FOV: 45 degrees.
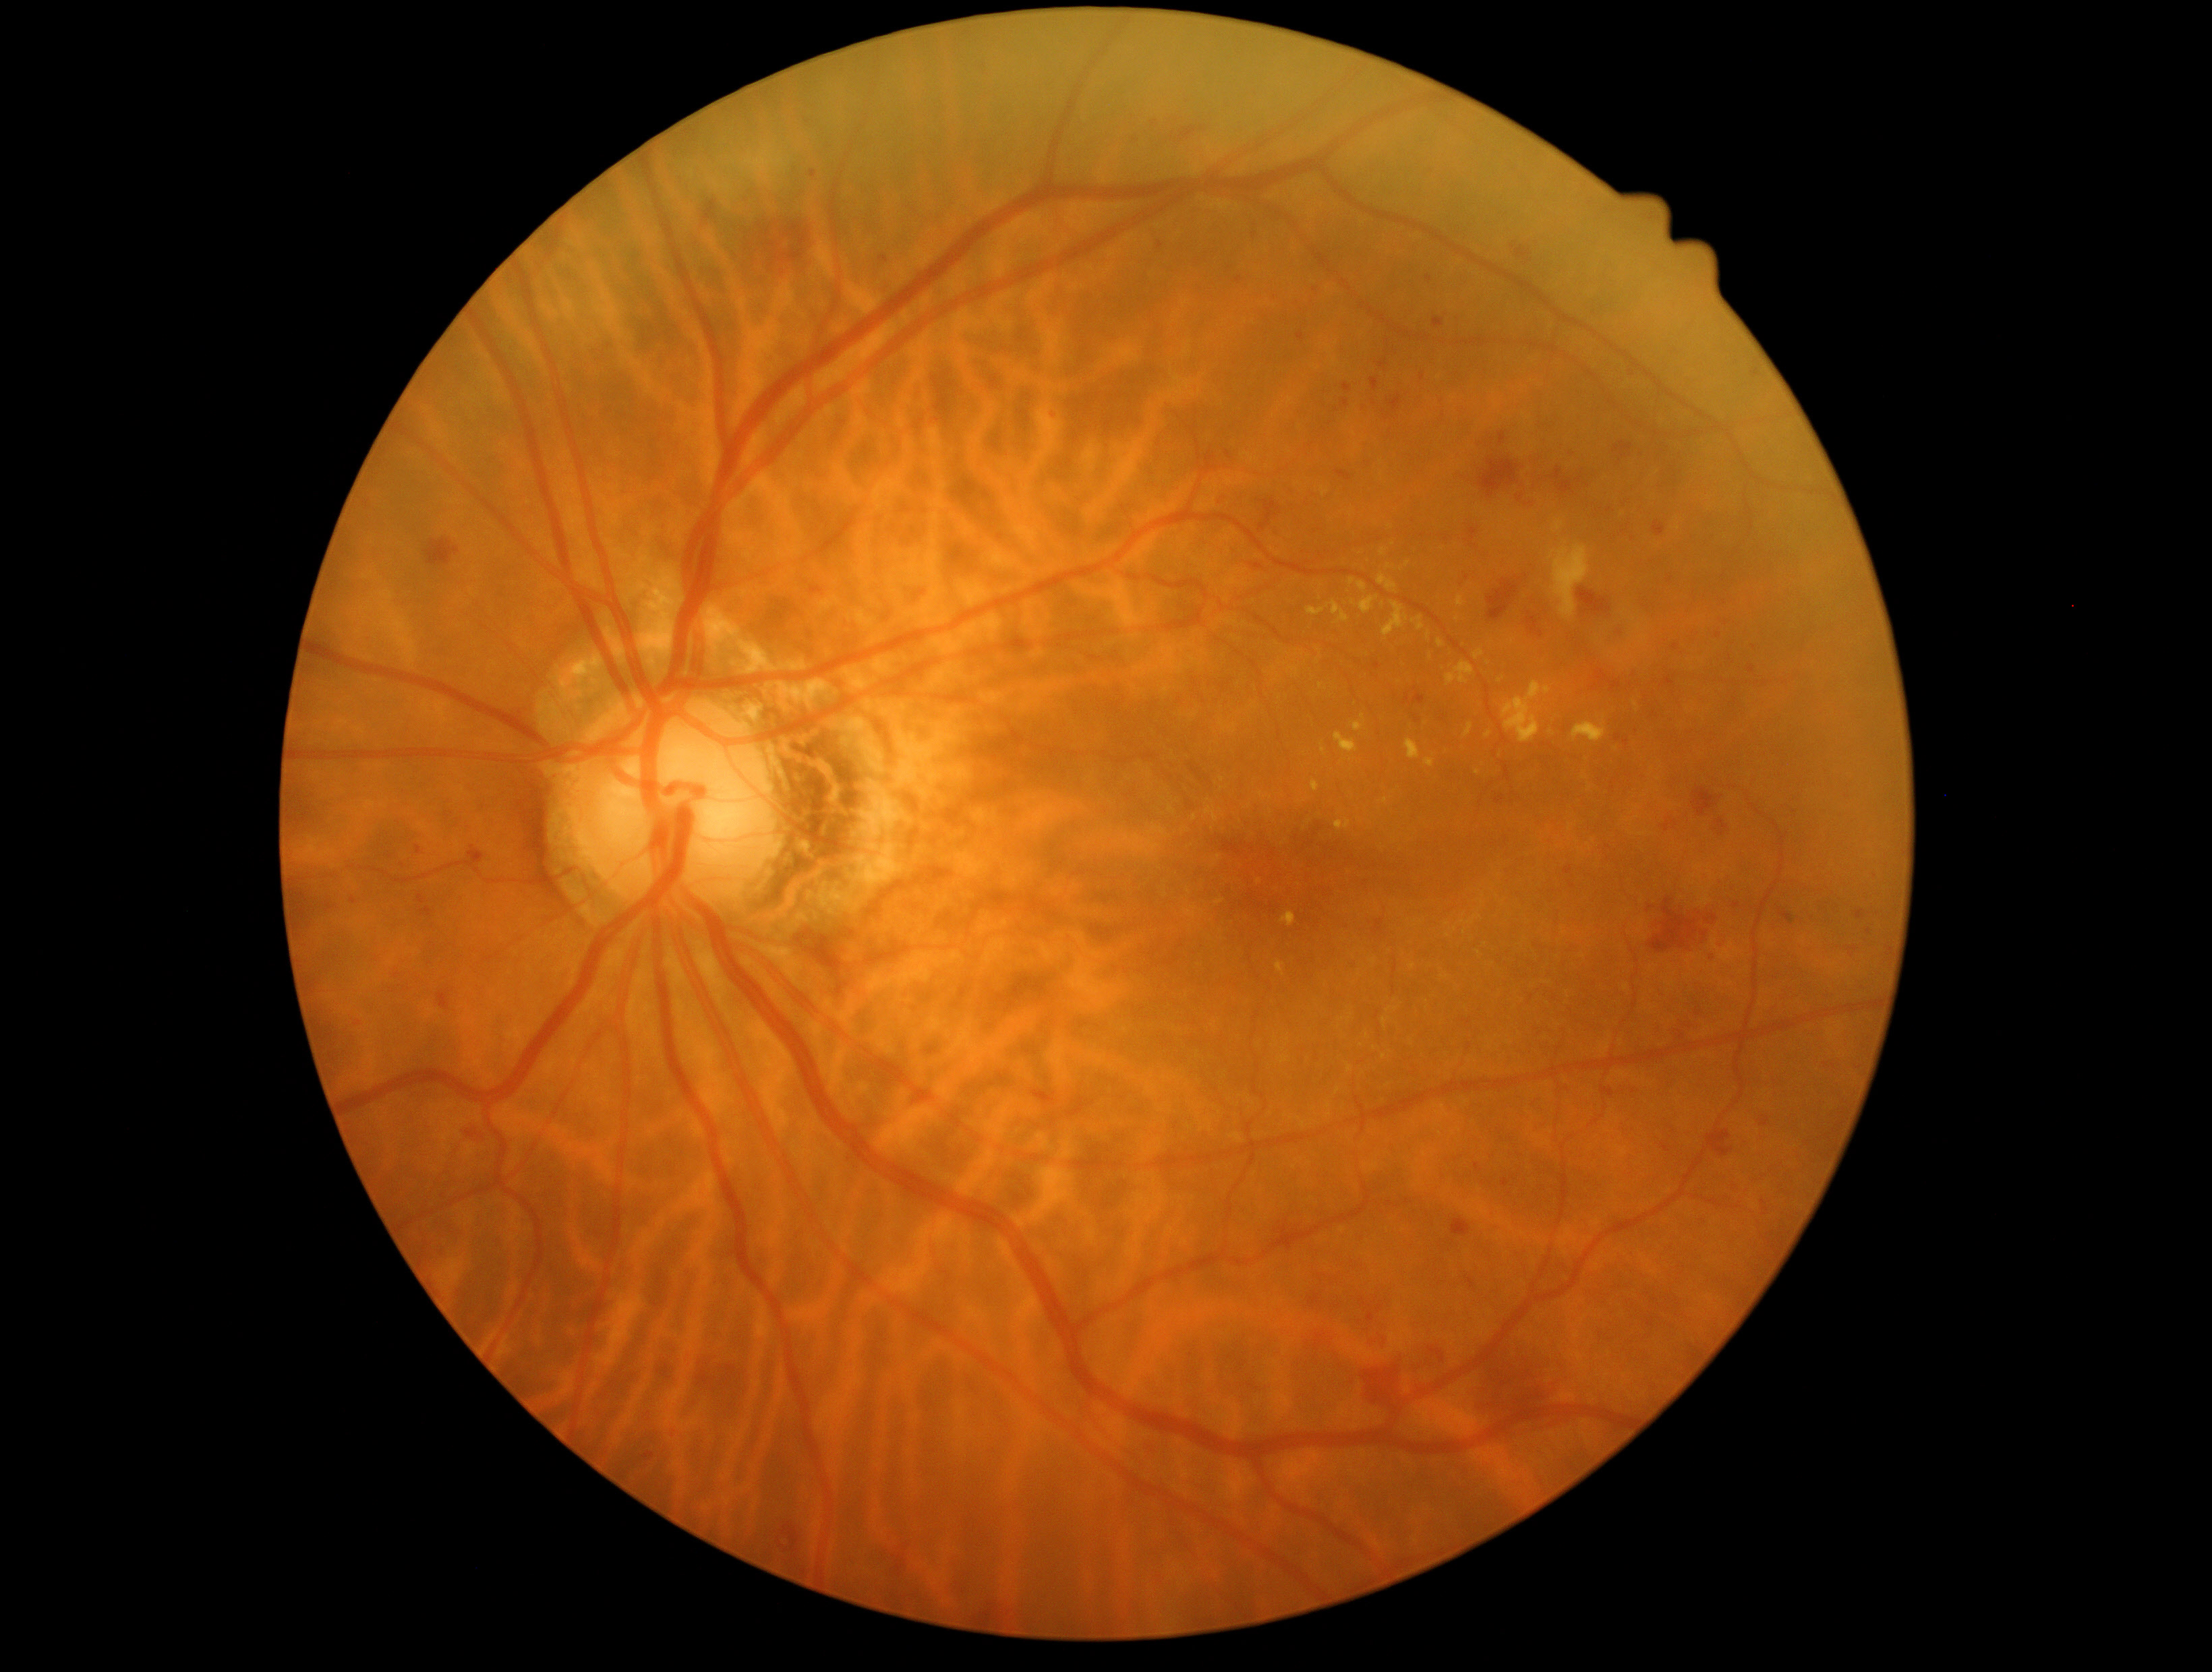 Diabetic retinopathy (DR) is moderate NPDR (grade 2)
Selected lesions:
- hemorrhages (HEs) (subset): <bbox>436, 1190, 450, 1202</bbox> | <bbox>970, 60, 992, 78</bbox> | <bbox>1631, 725, 1639, 737</bbox> | <bbox>728, 188, 825, 280</bbox> | <bbox>1304, 490, 1317, 509</bbox> | <bbox>1759, 1118, 1770, 1127</bbox> | <bbox>1576, 589, 1612, 617</bbox> | <bbox>1190, 256, 1204, 270</bbox> | <bbox>1371, 378, 1380, 392</bbox> | <bbox>703, 202, 718, 222</bbox> | <bbox>1174, 123, 1205, 145</bbox> | <bbox>778, 1541, 783, 1549</bbox> | <bbox>656, 1358, 676, 1383</bbox> | <bbox>1673, 644, 1680, 652</bbox> | <bbox>1407, 516, 1416, 524</bbox>
- Smaller HEs around 391, 858 | 1337, 410 | 1719, 635
- hard exudates (EXs) (subset): <bbox>1358, 582, 1367, 593</bbox> | <bbox>1383, 602, 1409, 637</bbox> | <bbox>1291, 668, 1300, 676</bbox> | <bbox>1281, 912, 1296, 927</bbox> | <bbox>1464, 723, 1475, 738</bbox> | <bbox>1355, 722, 1364, 732</bbox> | <bbox>1281, 1056, 1289, 1063</bbox> | <bbox>1331, 601, 1349, 625</bbox>
- Smaller EXs around 1448, 936 | 1489, 735 | 1431, 657 | 1500, 681 | 1196, 909 | 1477, 916 | 1195, 818 | 1585, 778 | 1383, 552